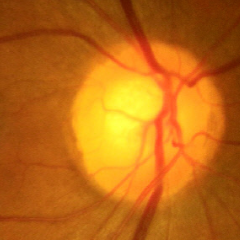
No glaucomatous optic neuropathy.